Nonmydriatic fundus photograph, image size 848x848, 45-degree field of view: 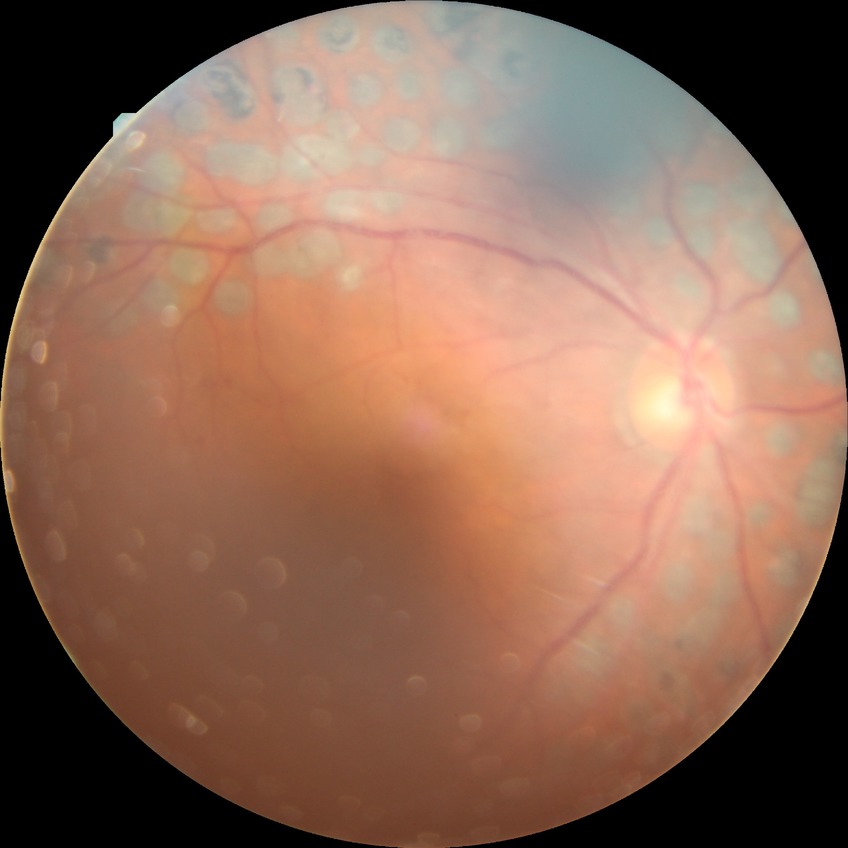

Annotations:
* diabetic retinopathy (DR): proliferative diabetic retinopathy (PDR)